NIDEK AFC-230:
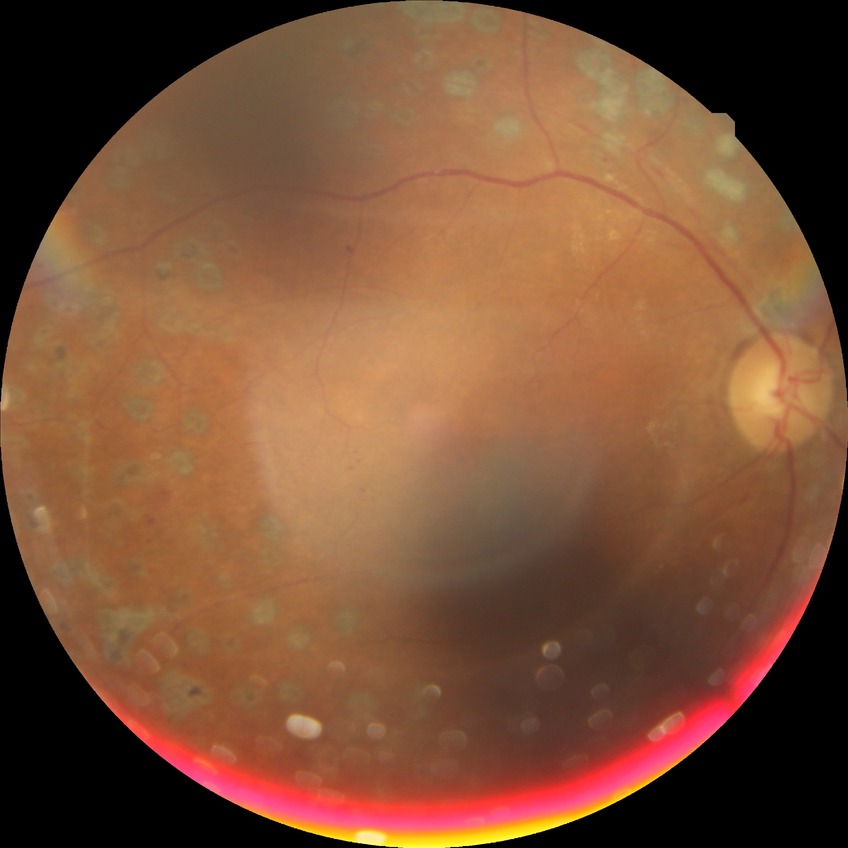 Diabetic retinopathy severity is proliferative diabetic retinopathy.